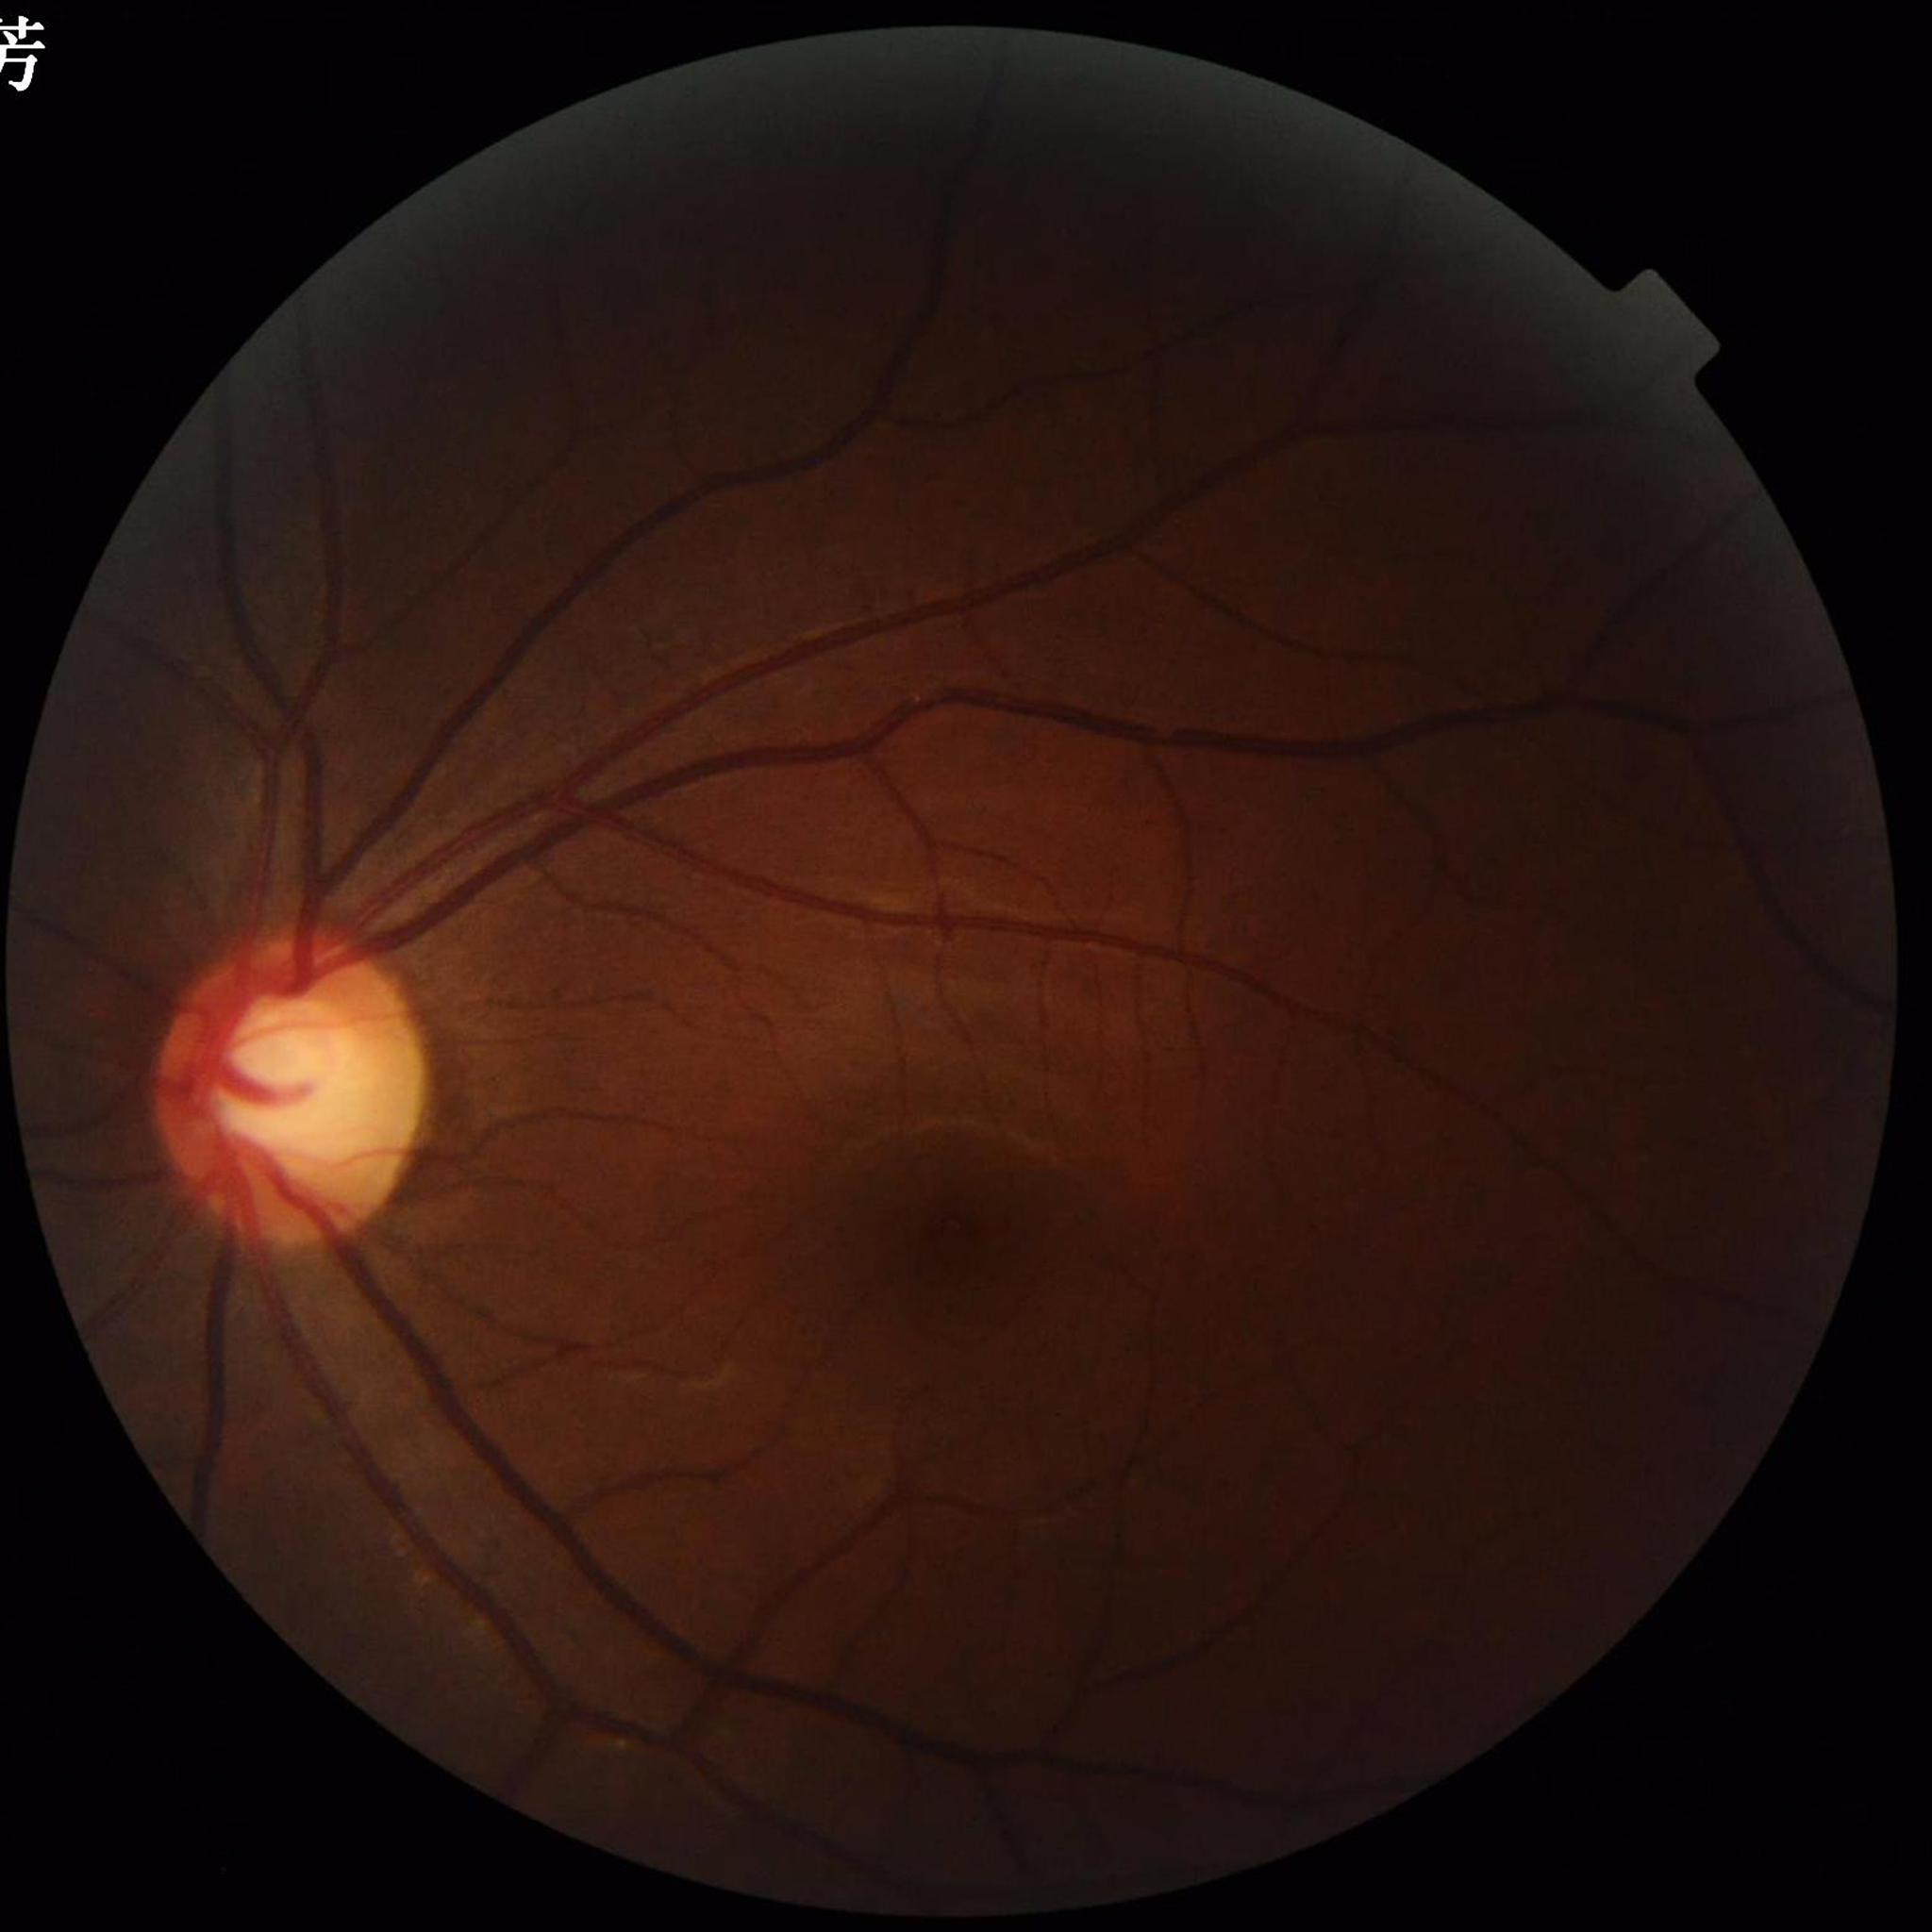 Condition = glaucoma | Photo quality = issues noted — illumination/color distortion.